Portable fundus photograph: 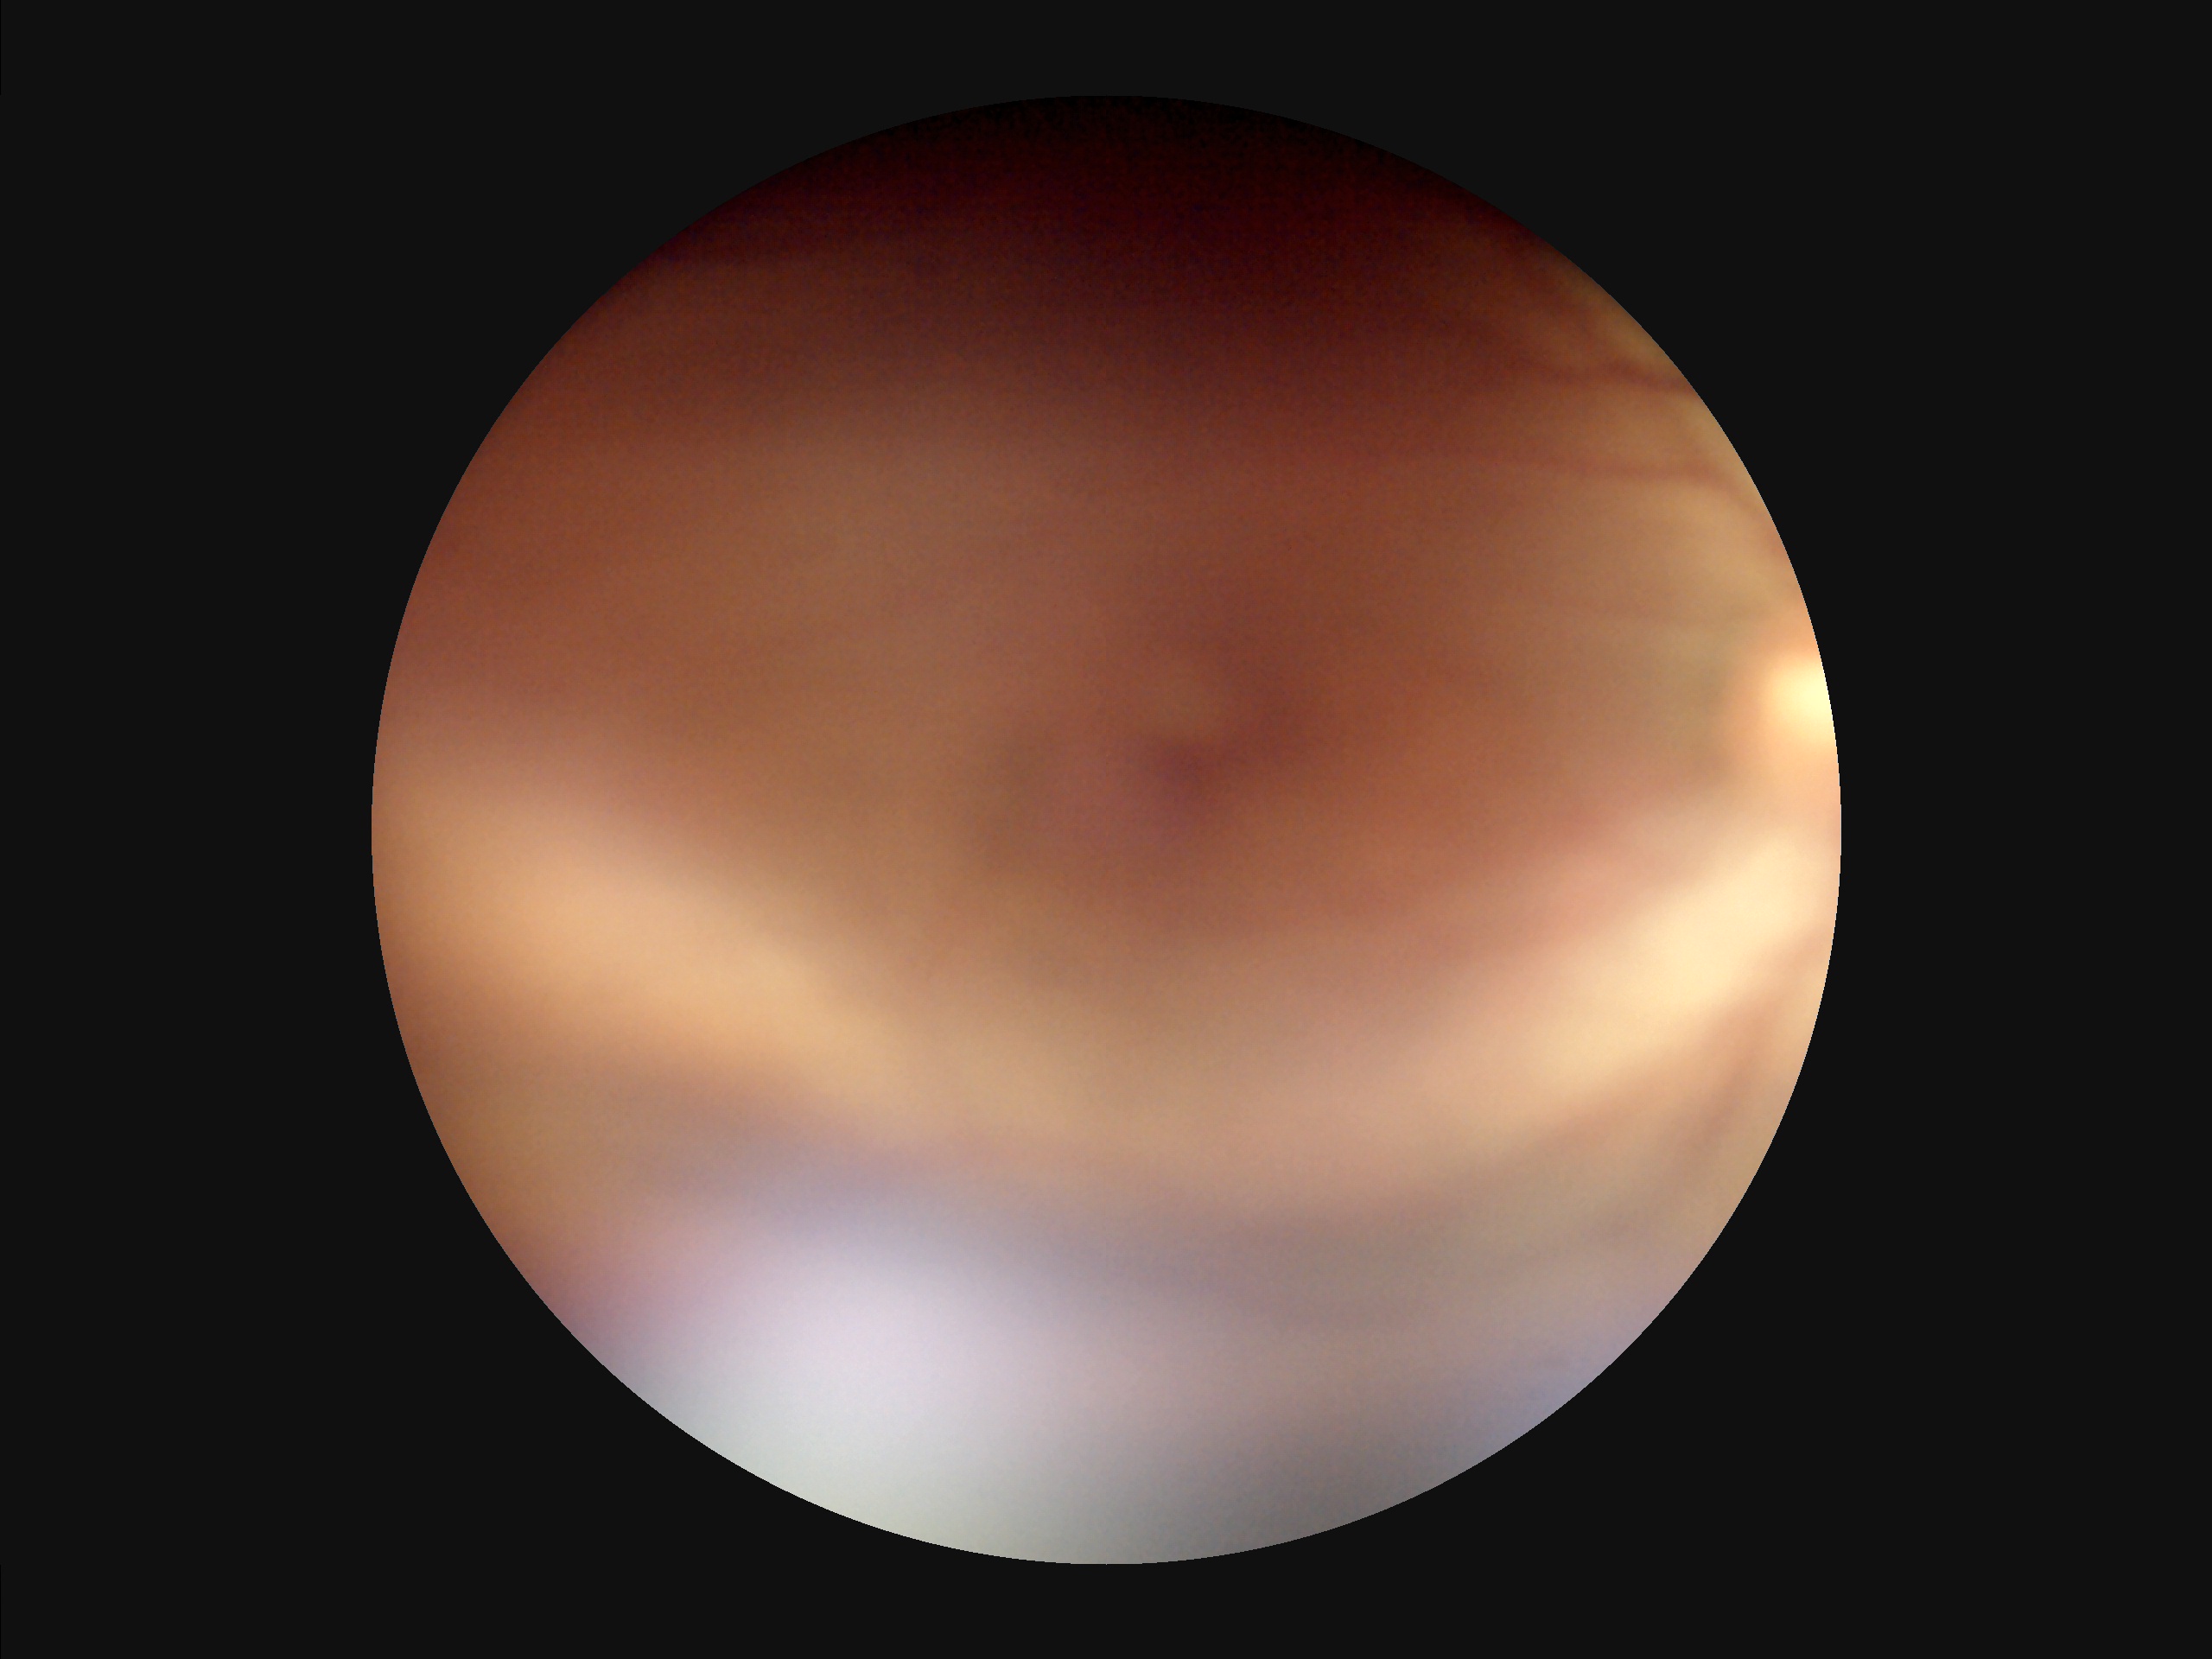 Contrast is low.
Image quality is inadequate for diagnostic use.
Reduced sharpness with visible blur.
There is over- or under-exposure or a color cast.